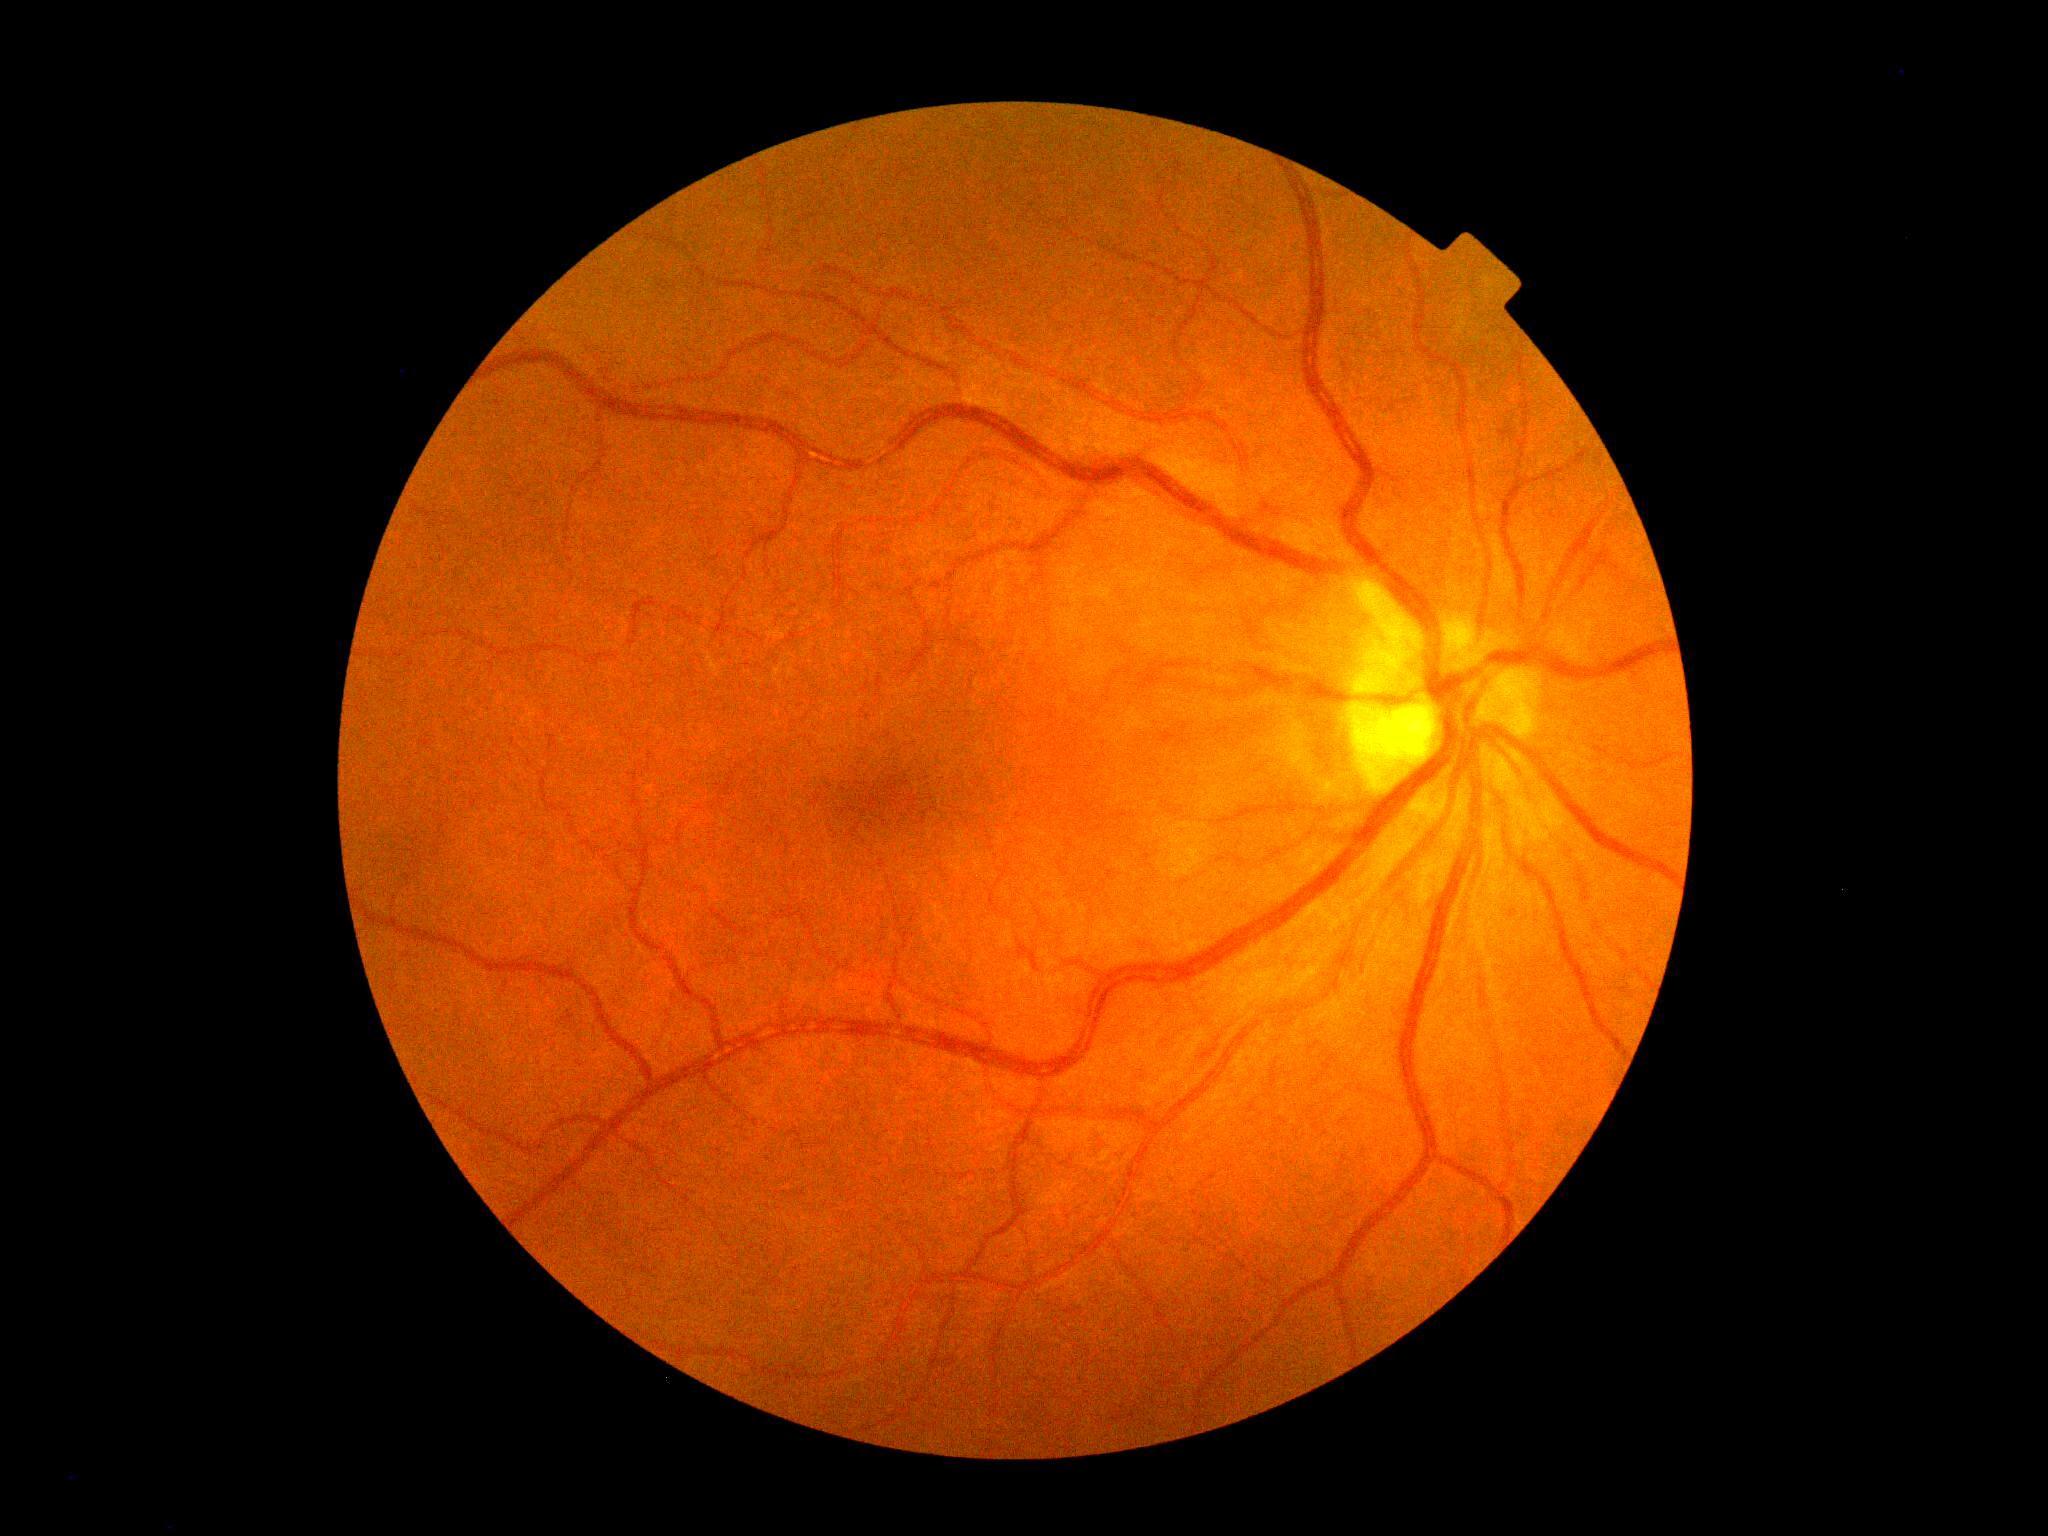
DR stage is 0/4. No DR findings.